Retinal fundus photograph. 2228x1652. Central posterior field. Captured on a Topcon TRC-50DX fundus camera:
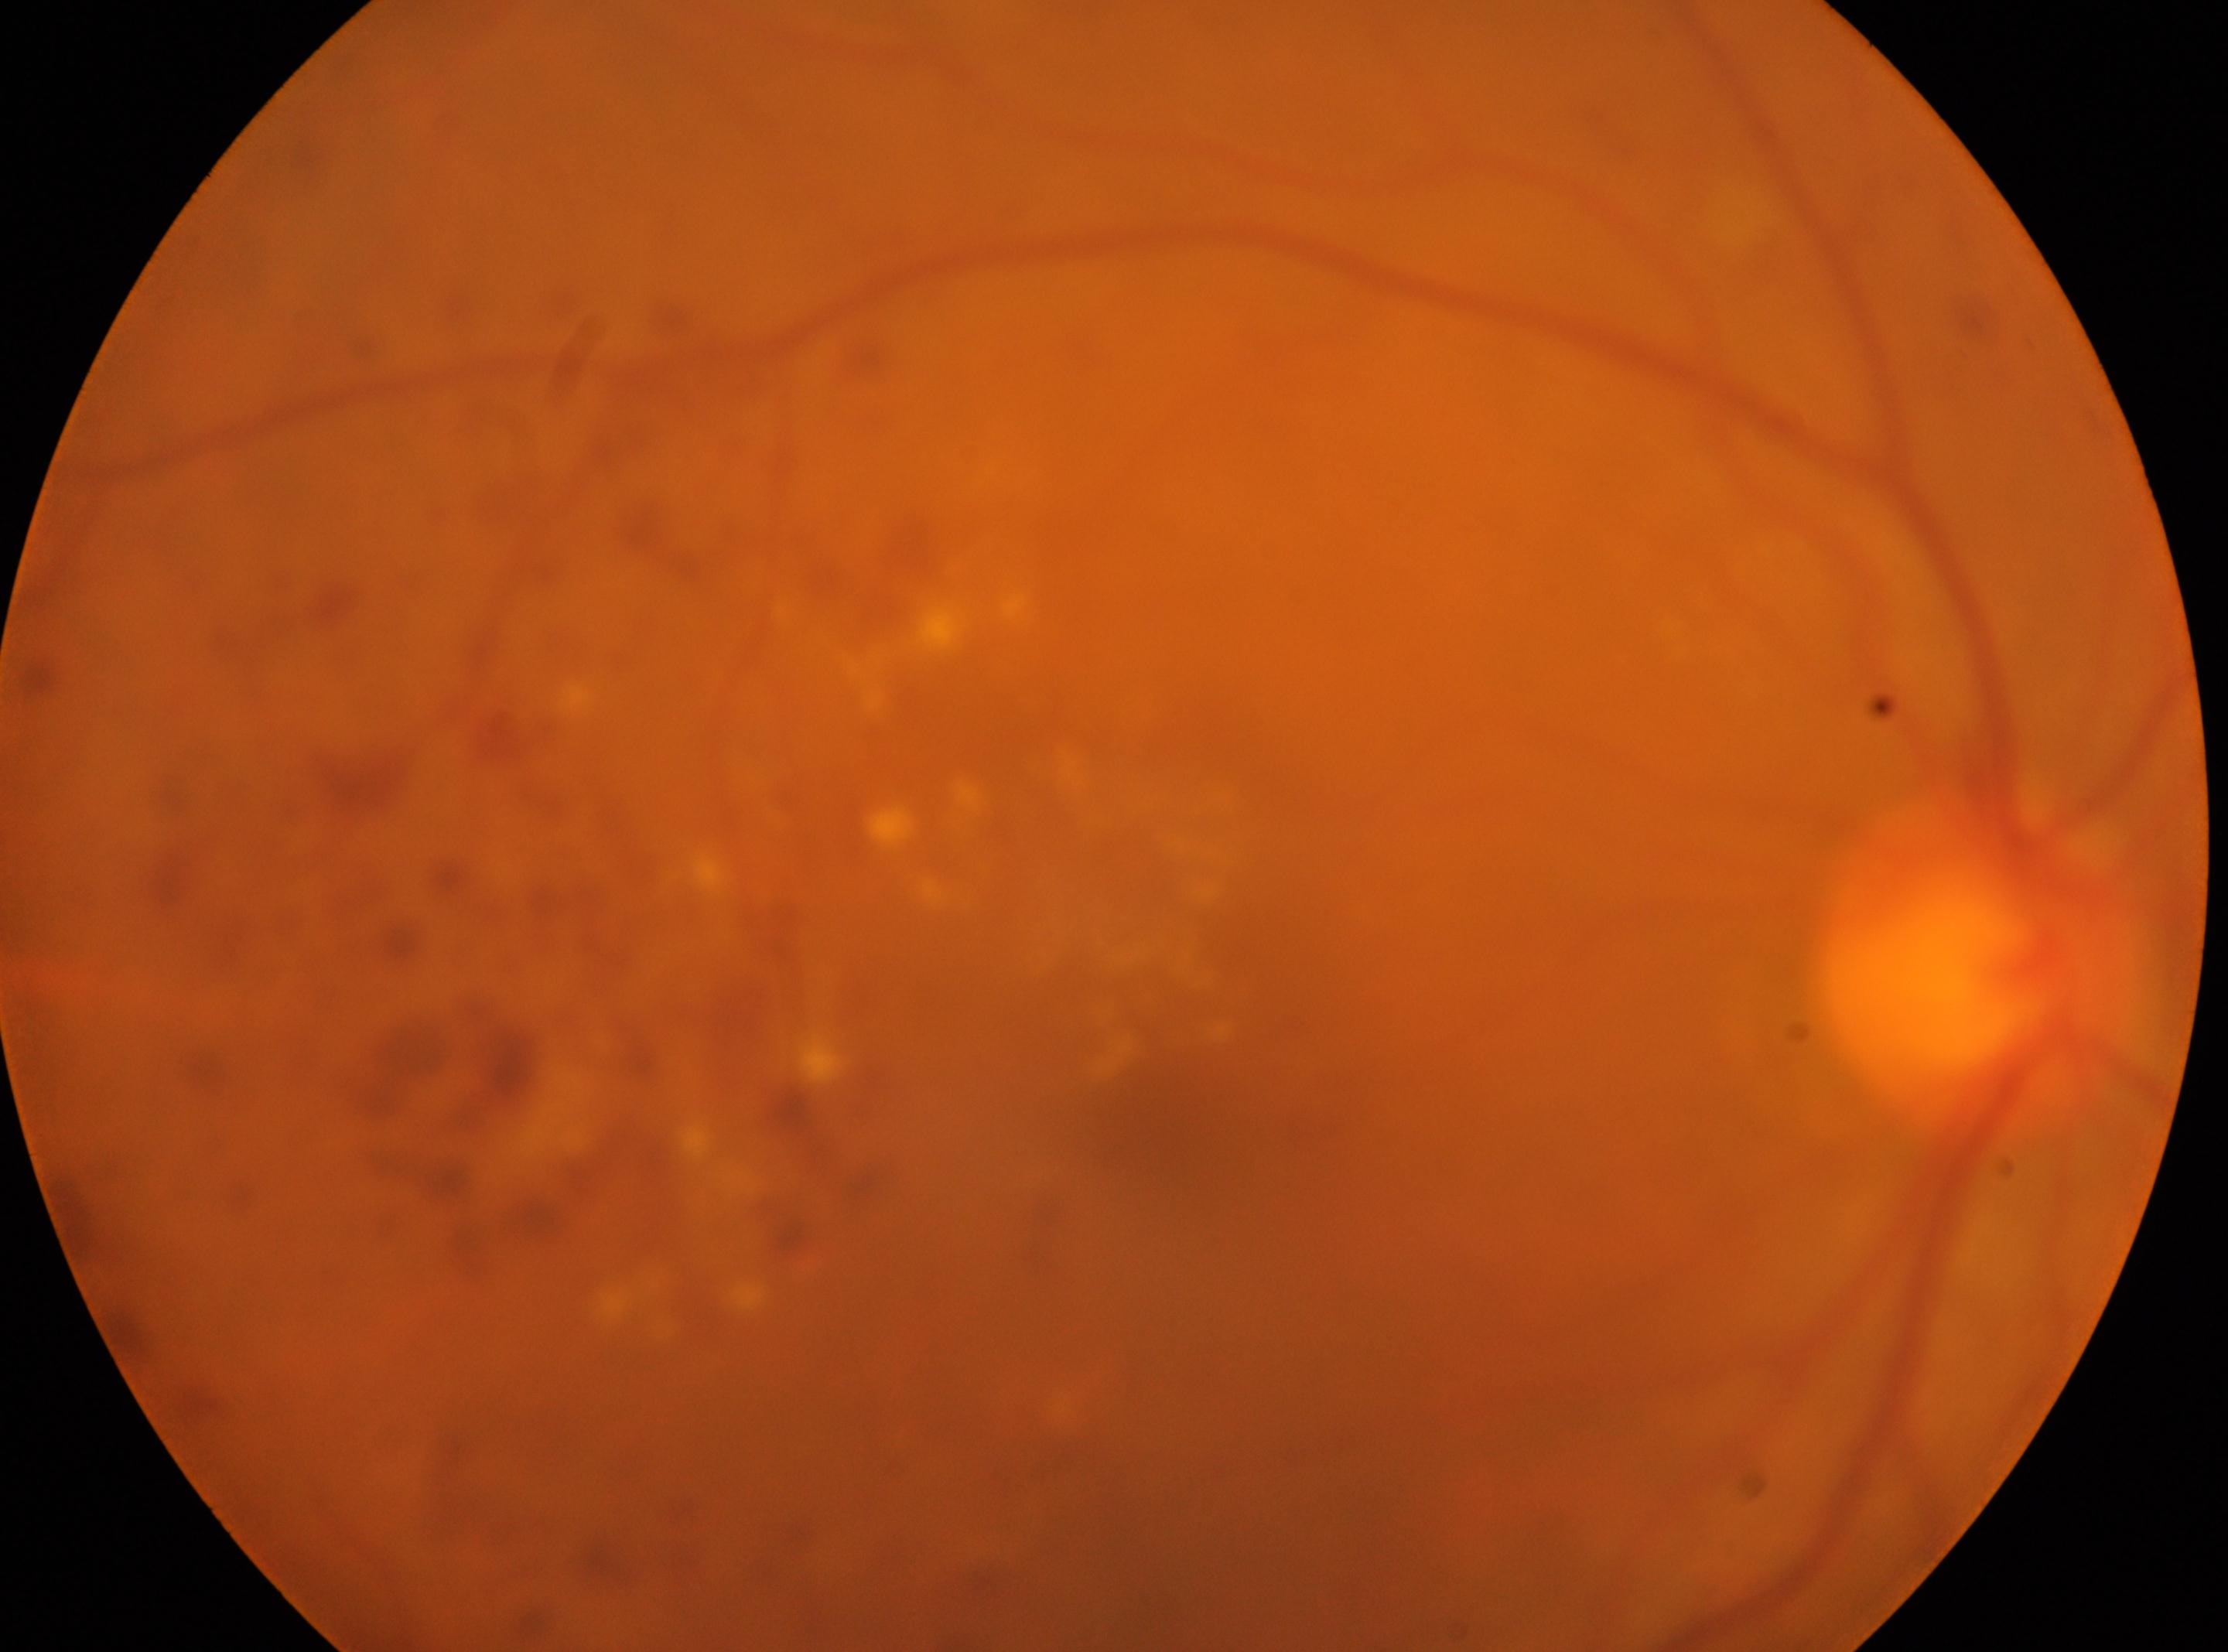 Eye: the right eye. Diabetic retinopathy severity is grade 2 (moderate NPDR). Macula center: 1160, 1126. Optic disc located at 1980, 973.